NIDEK AFC-230. Davis DR grading. 45 degree fundus photograph. Fundus photo. 848 x 848 pixels
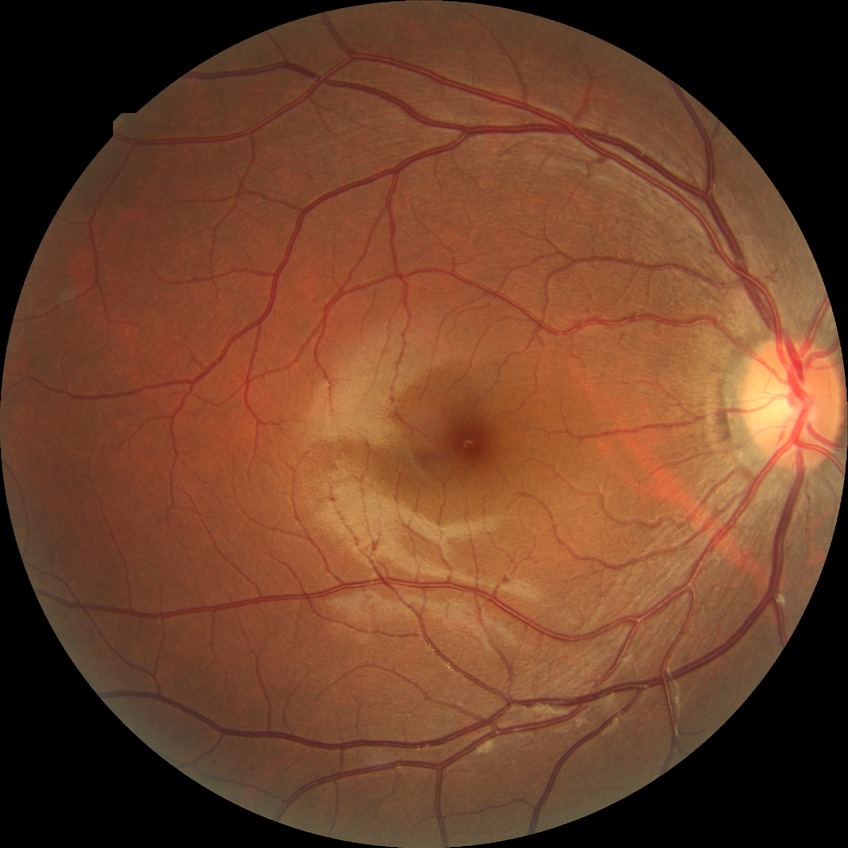
Diabetic retinopathy (DR): no diabetic retinopathy (NDR).